Without pupil dilation, 848x848px: 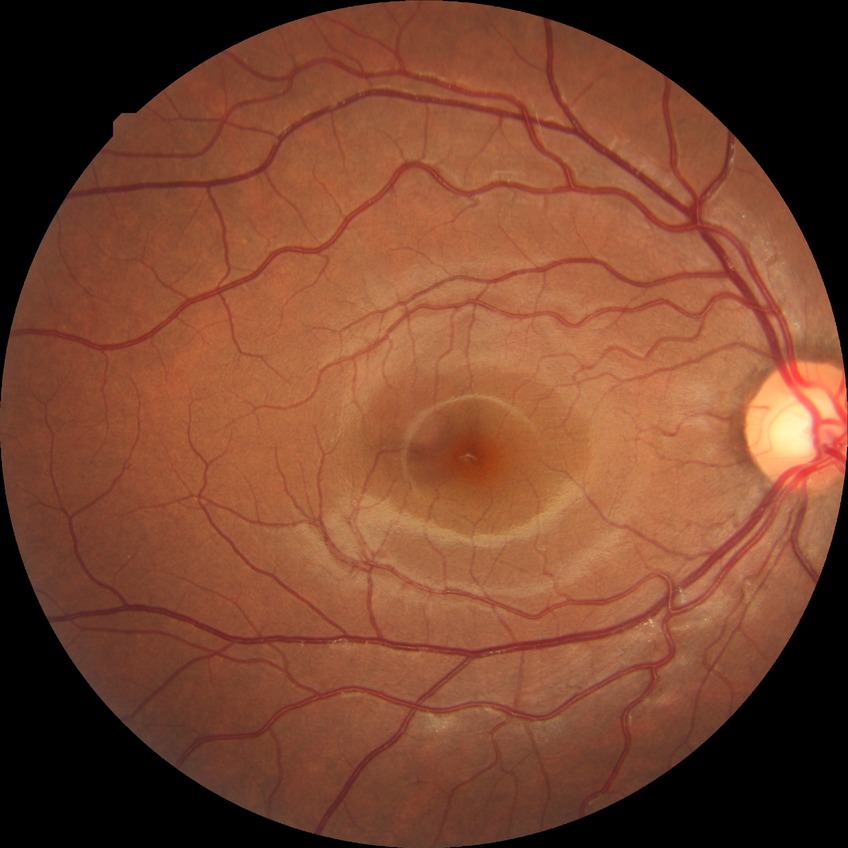
Assessment:
• modified Davis classification — no diabetic retinopathy